Fundus photo. Without pupil dilation. 45° FOV. NIDEK AFC-230. Graded on the modified Davis scale: 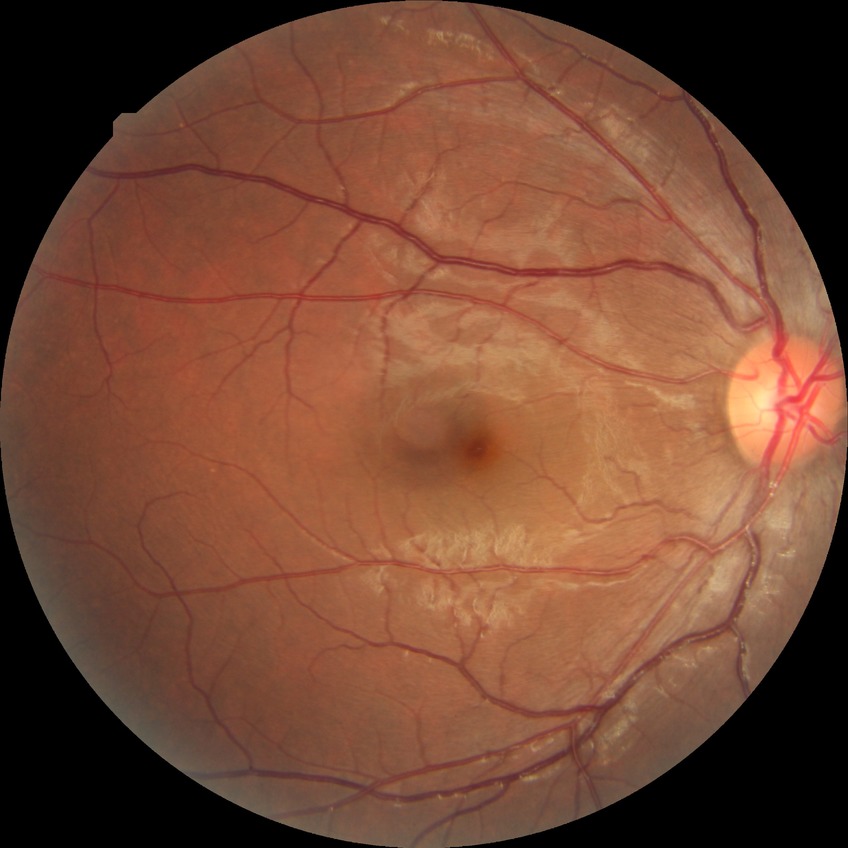
Retinopathy stage: simple diabetic retinopathy.